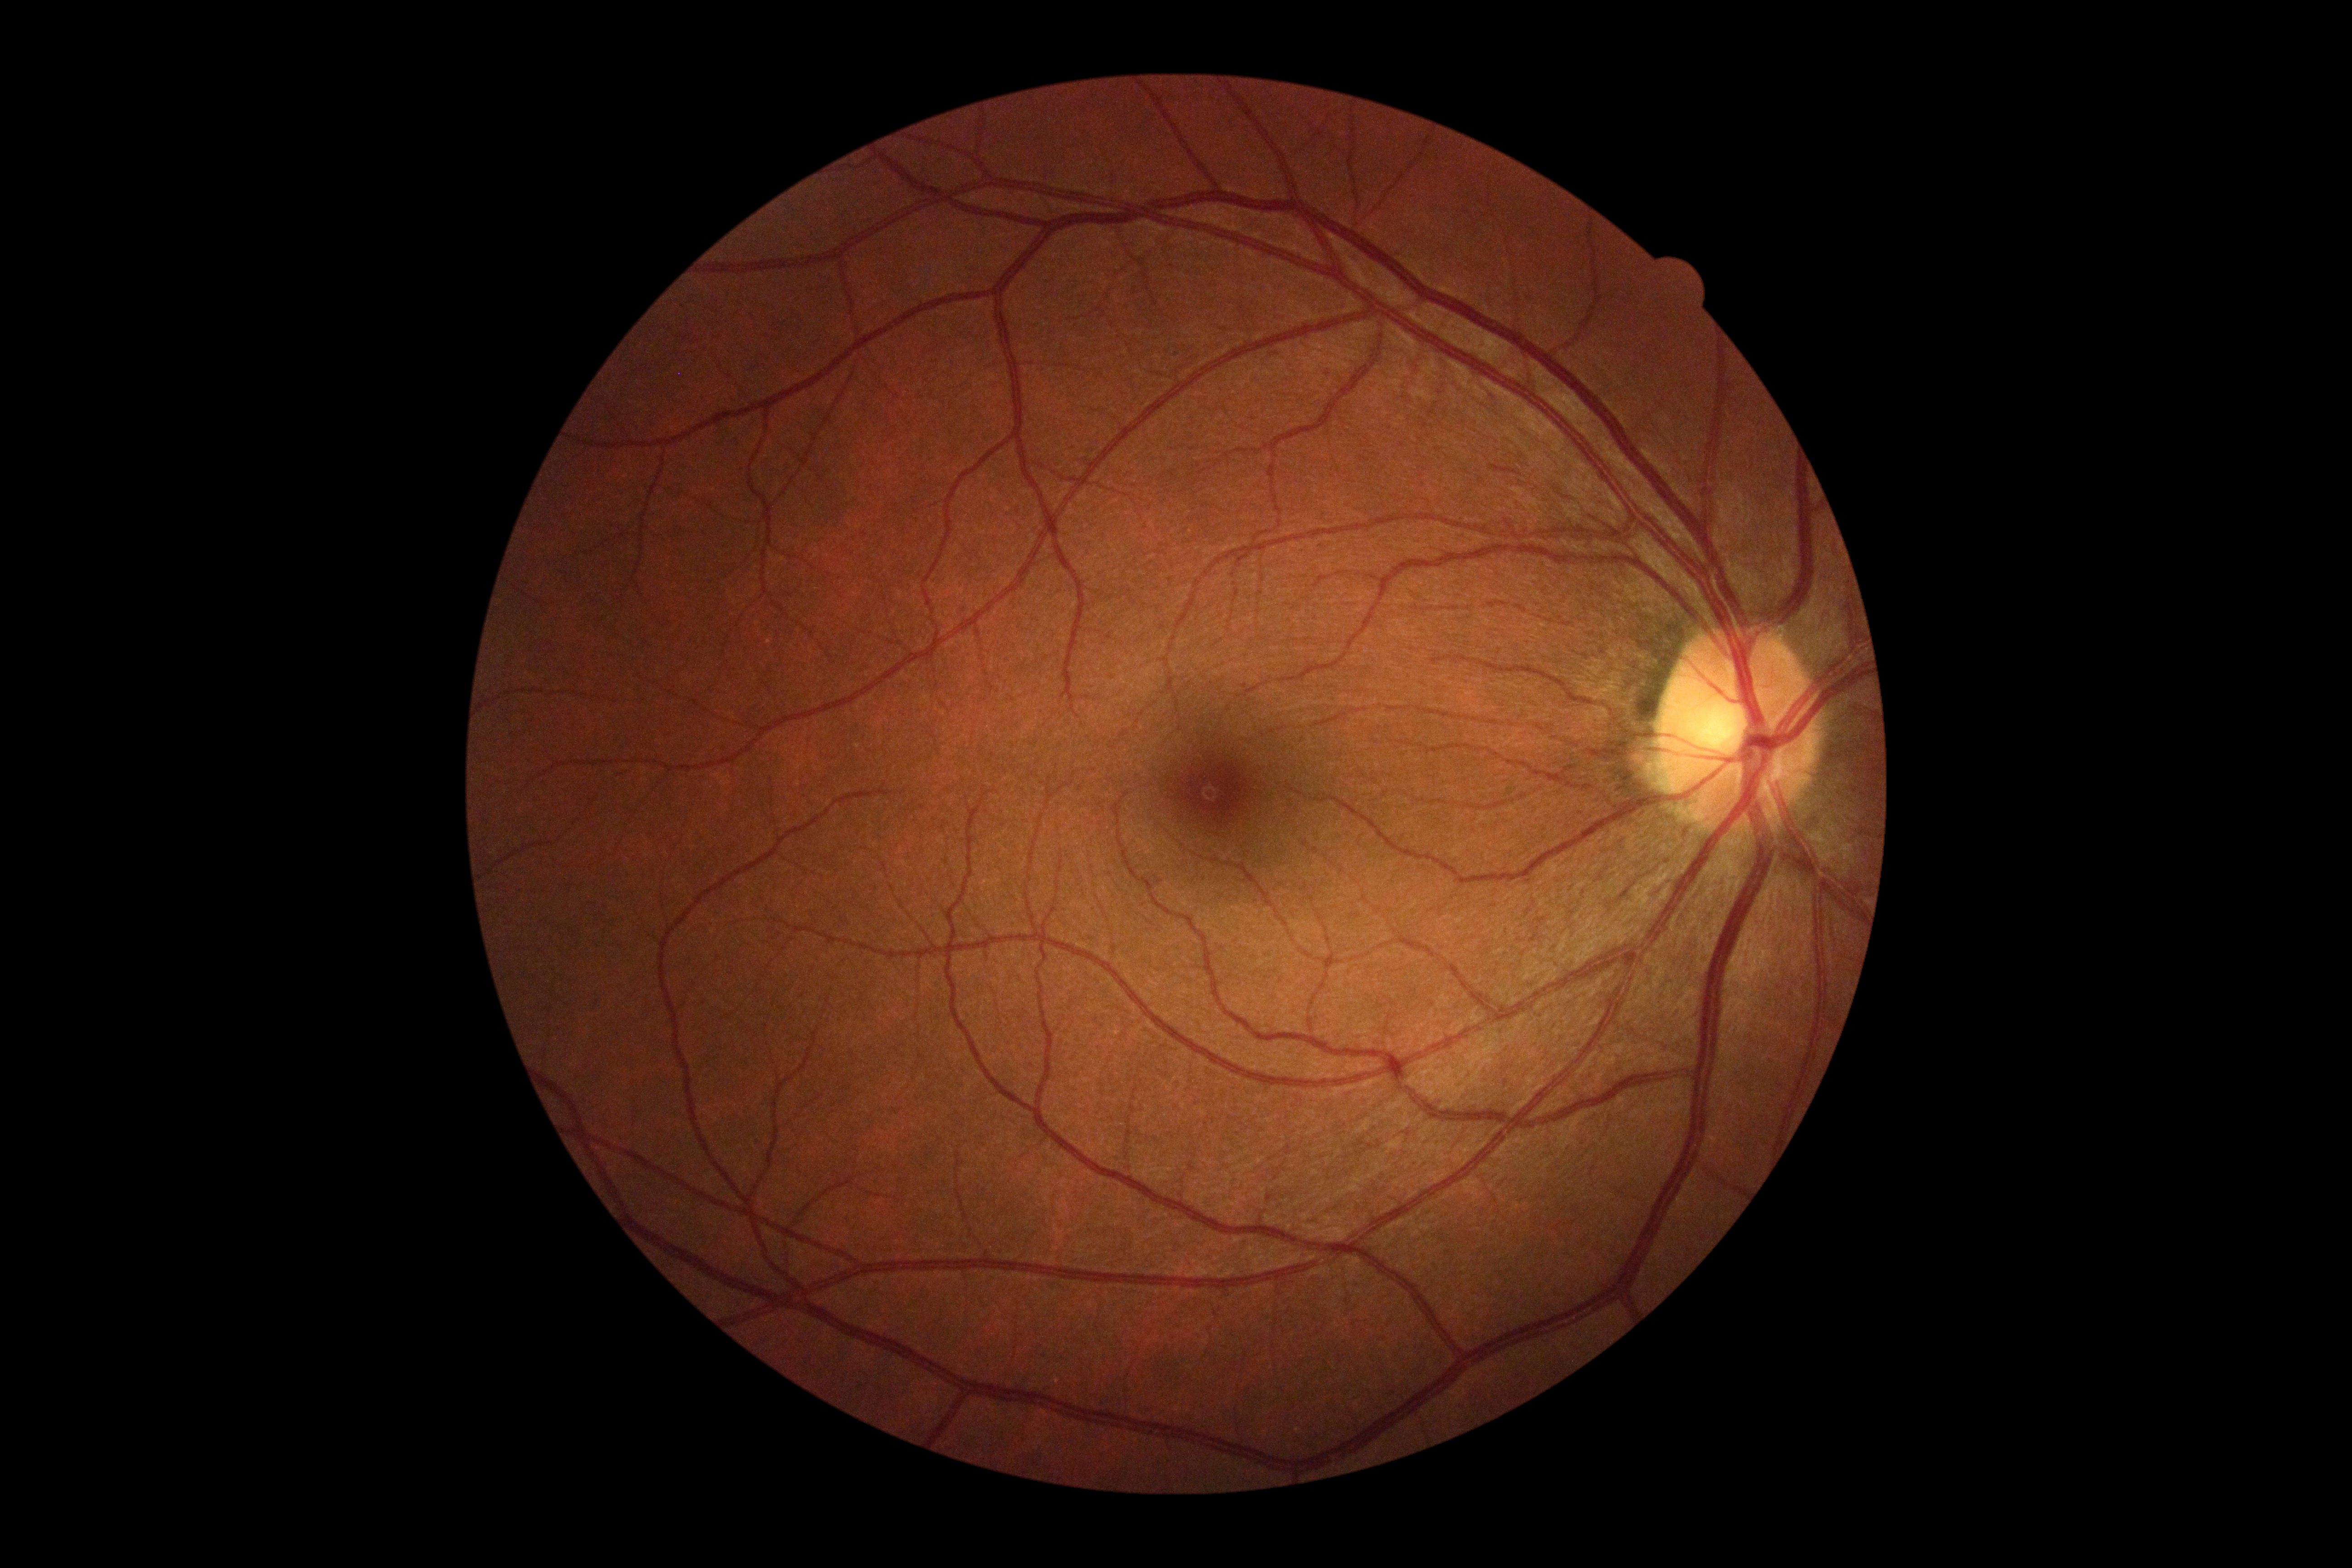

– retinopathy — no apparent diabetic retinopathy (grade 0) — no visible signs of diabetic retinopathy